Camera: Natus RetCam Envision (130° FOV). Wide-field fundus image from infant ROP screening.
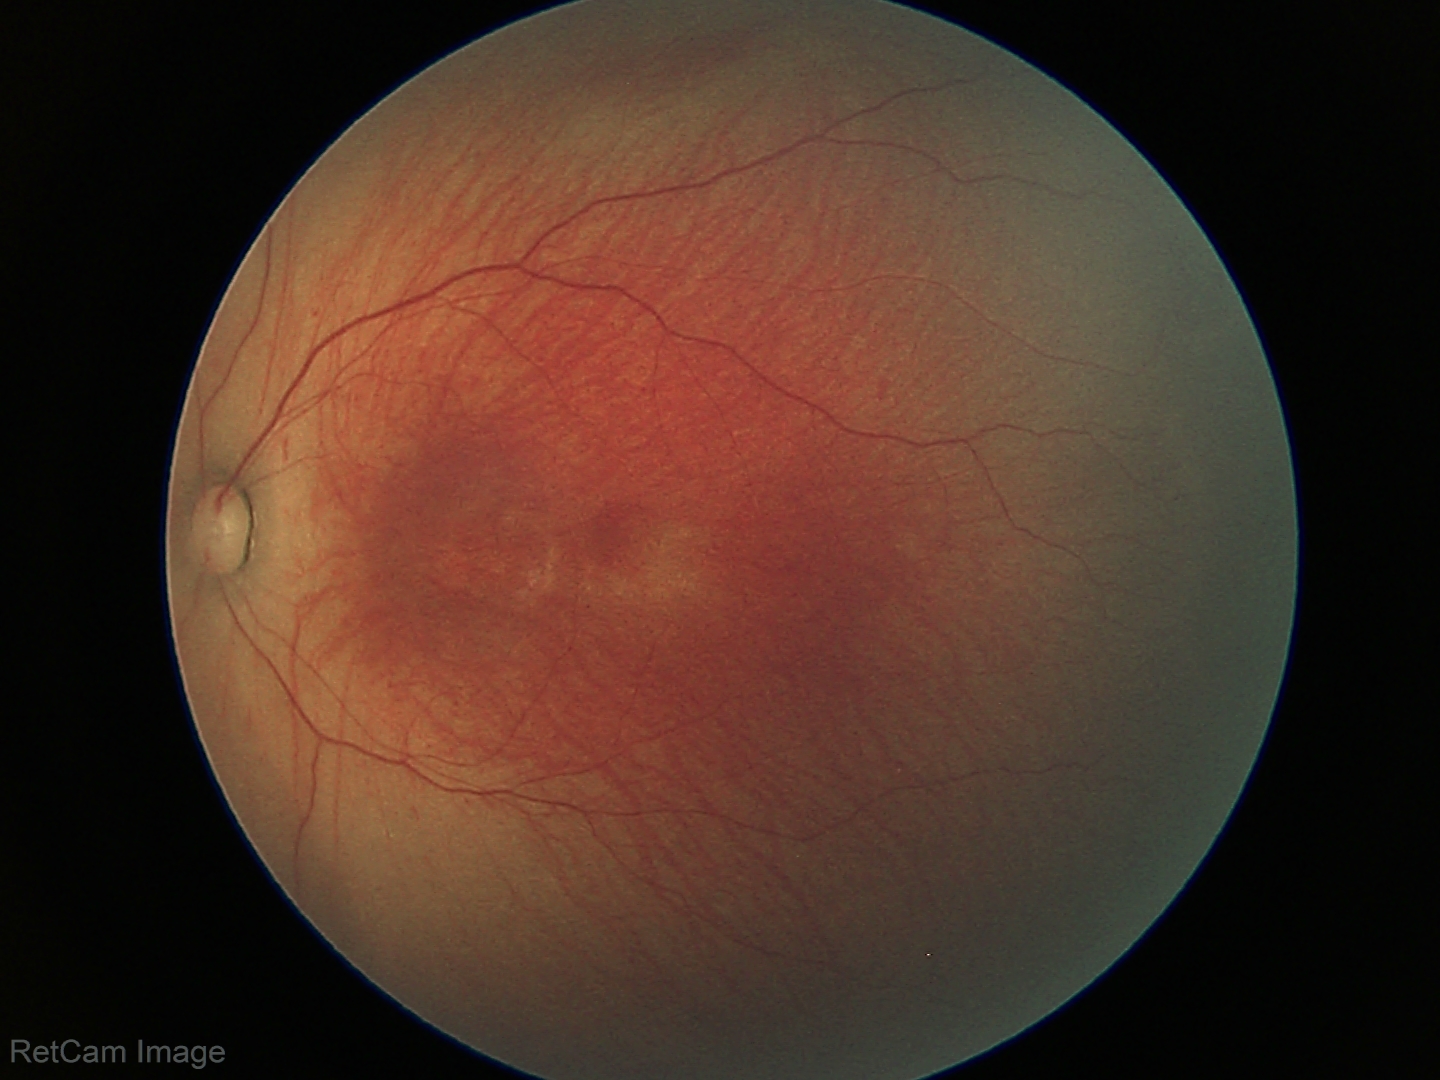

Diagnosis from this screening exam: retinopathy of prematurity stage 1.